45-degree field of view · retinal fundus photograph · image size 2346x1568 — 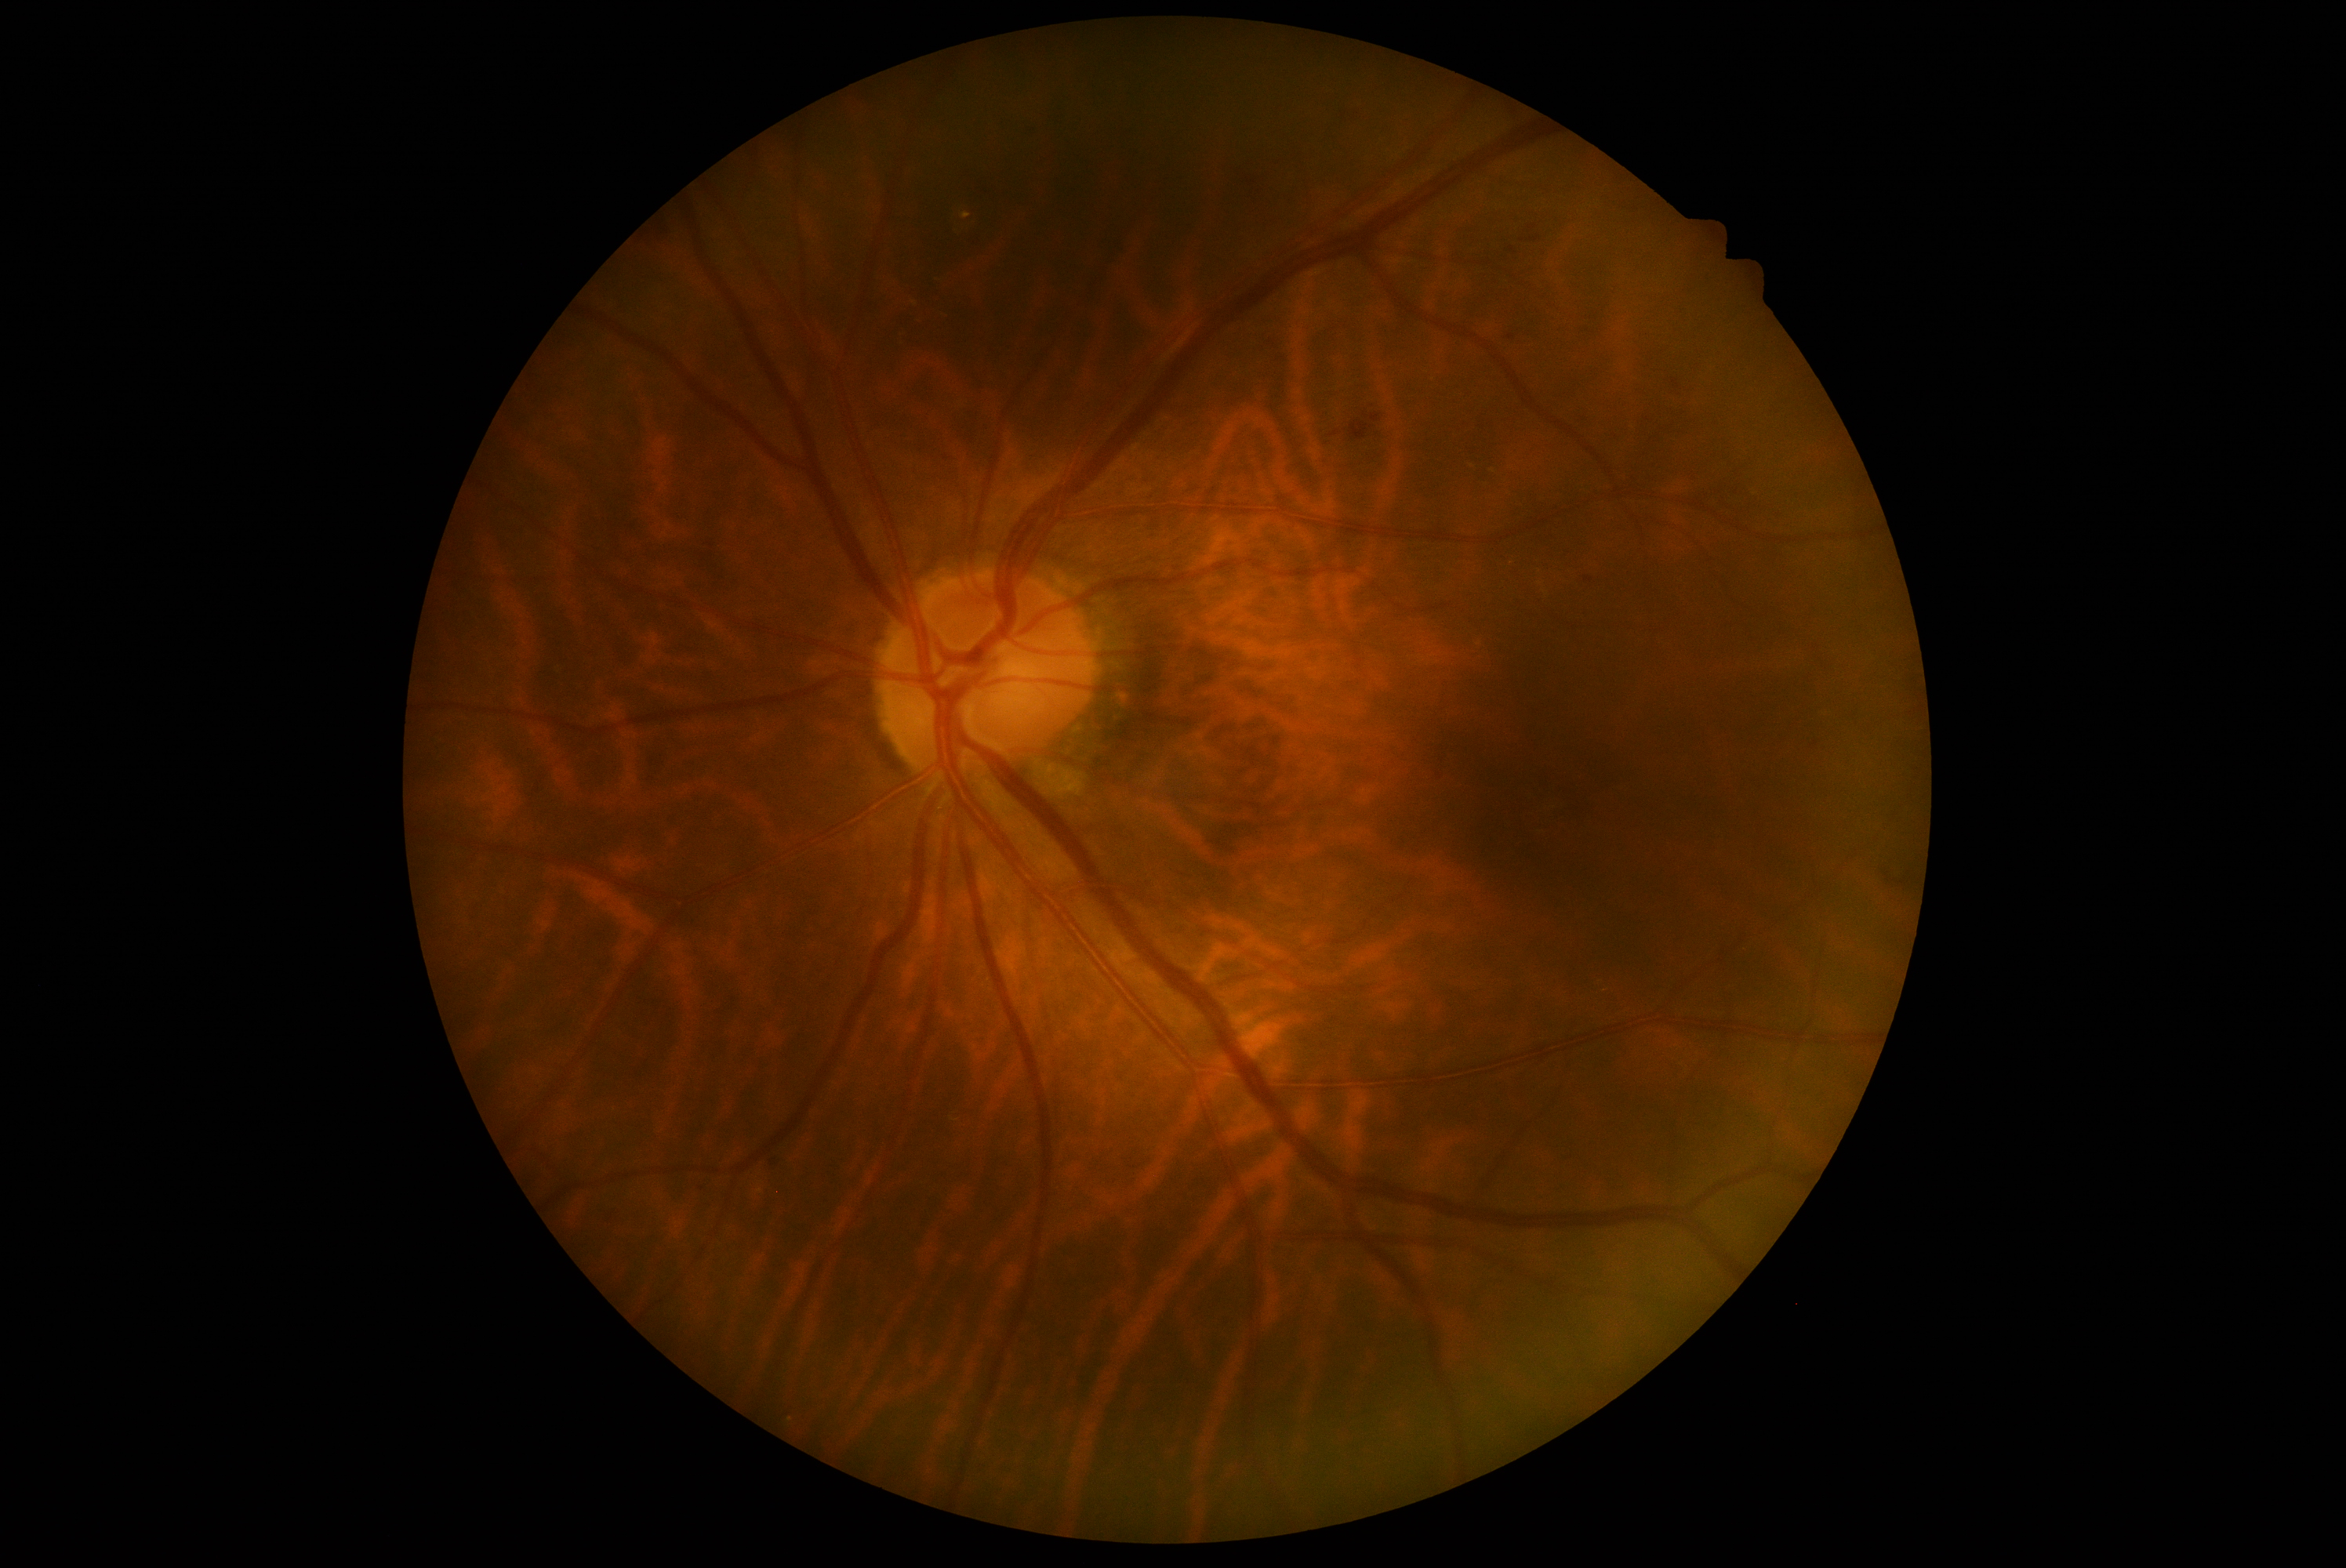
DR: 2.